Modified Davis classification. Image size 848x848:
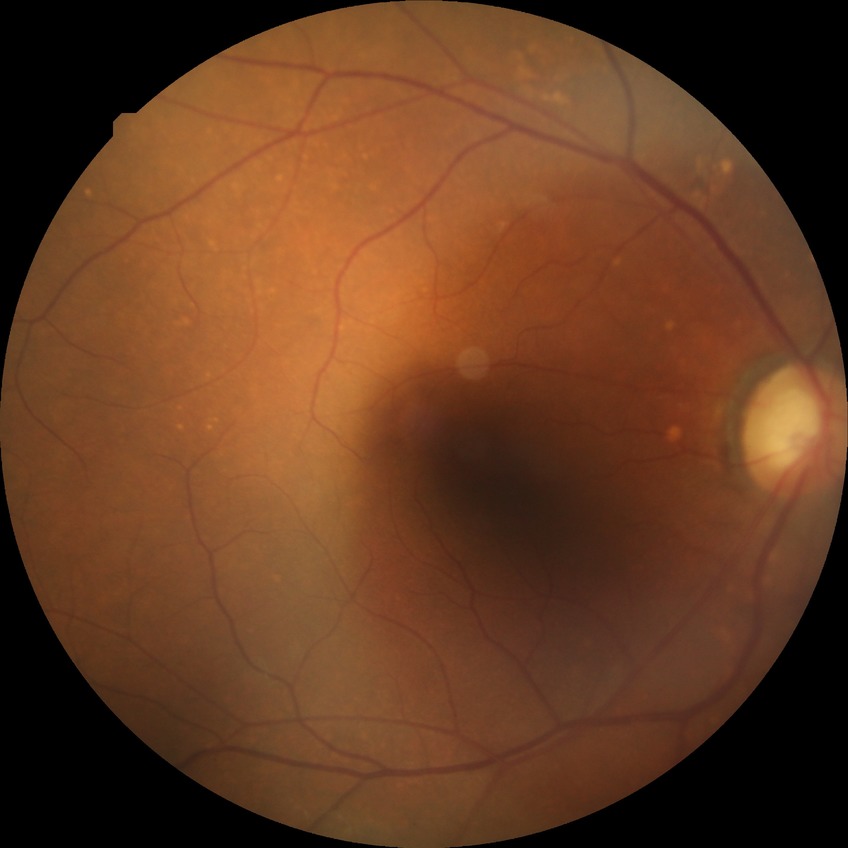 Diabetic retinopathy (DR): no diabetic retinopathy (NDR).